FOV: 45 degrees: 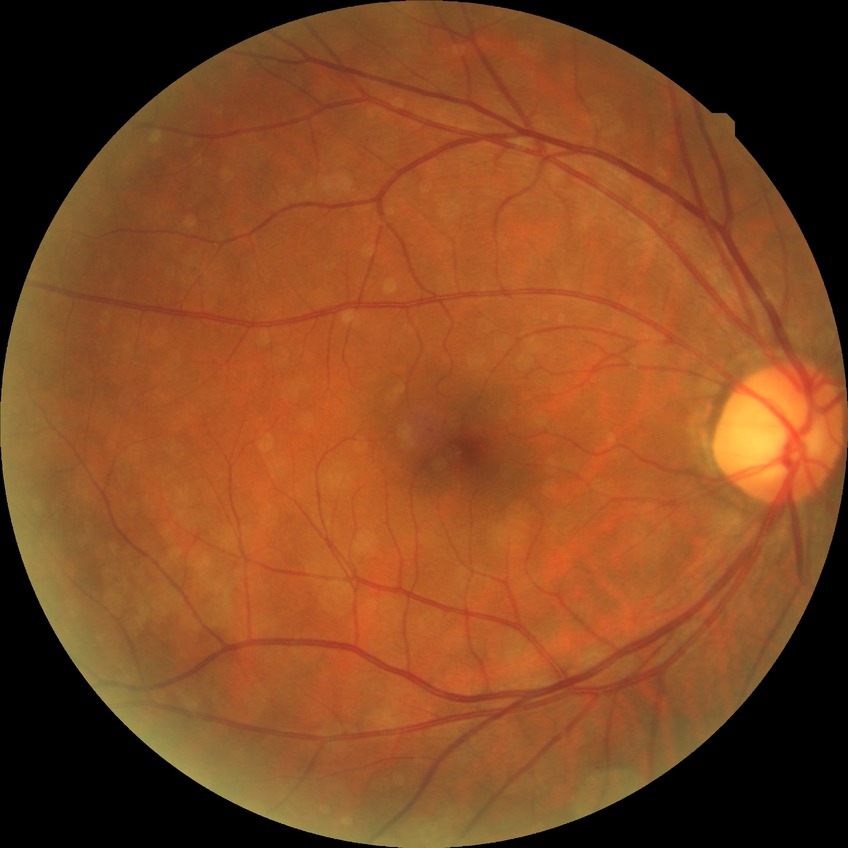

Modified Davis grading is simple diabetic retinopathy.